2048x1536 — 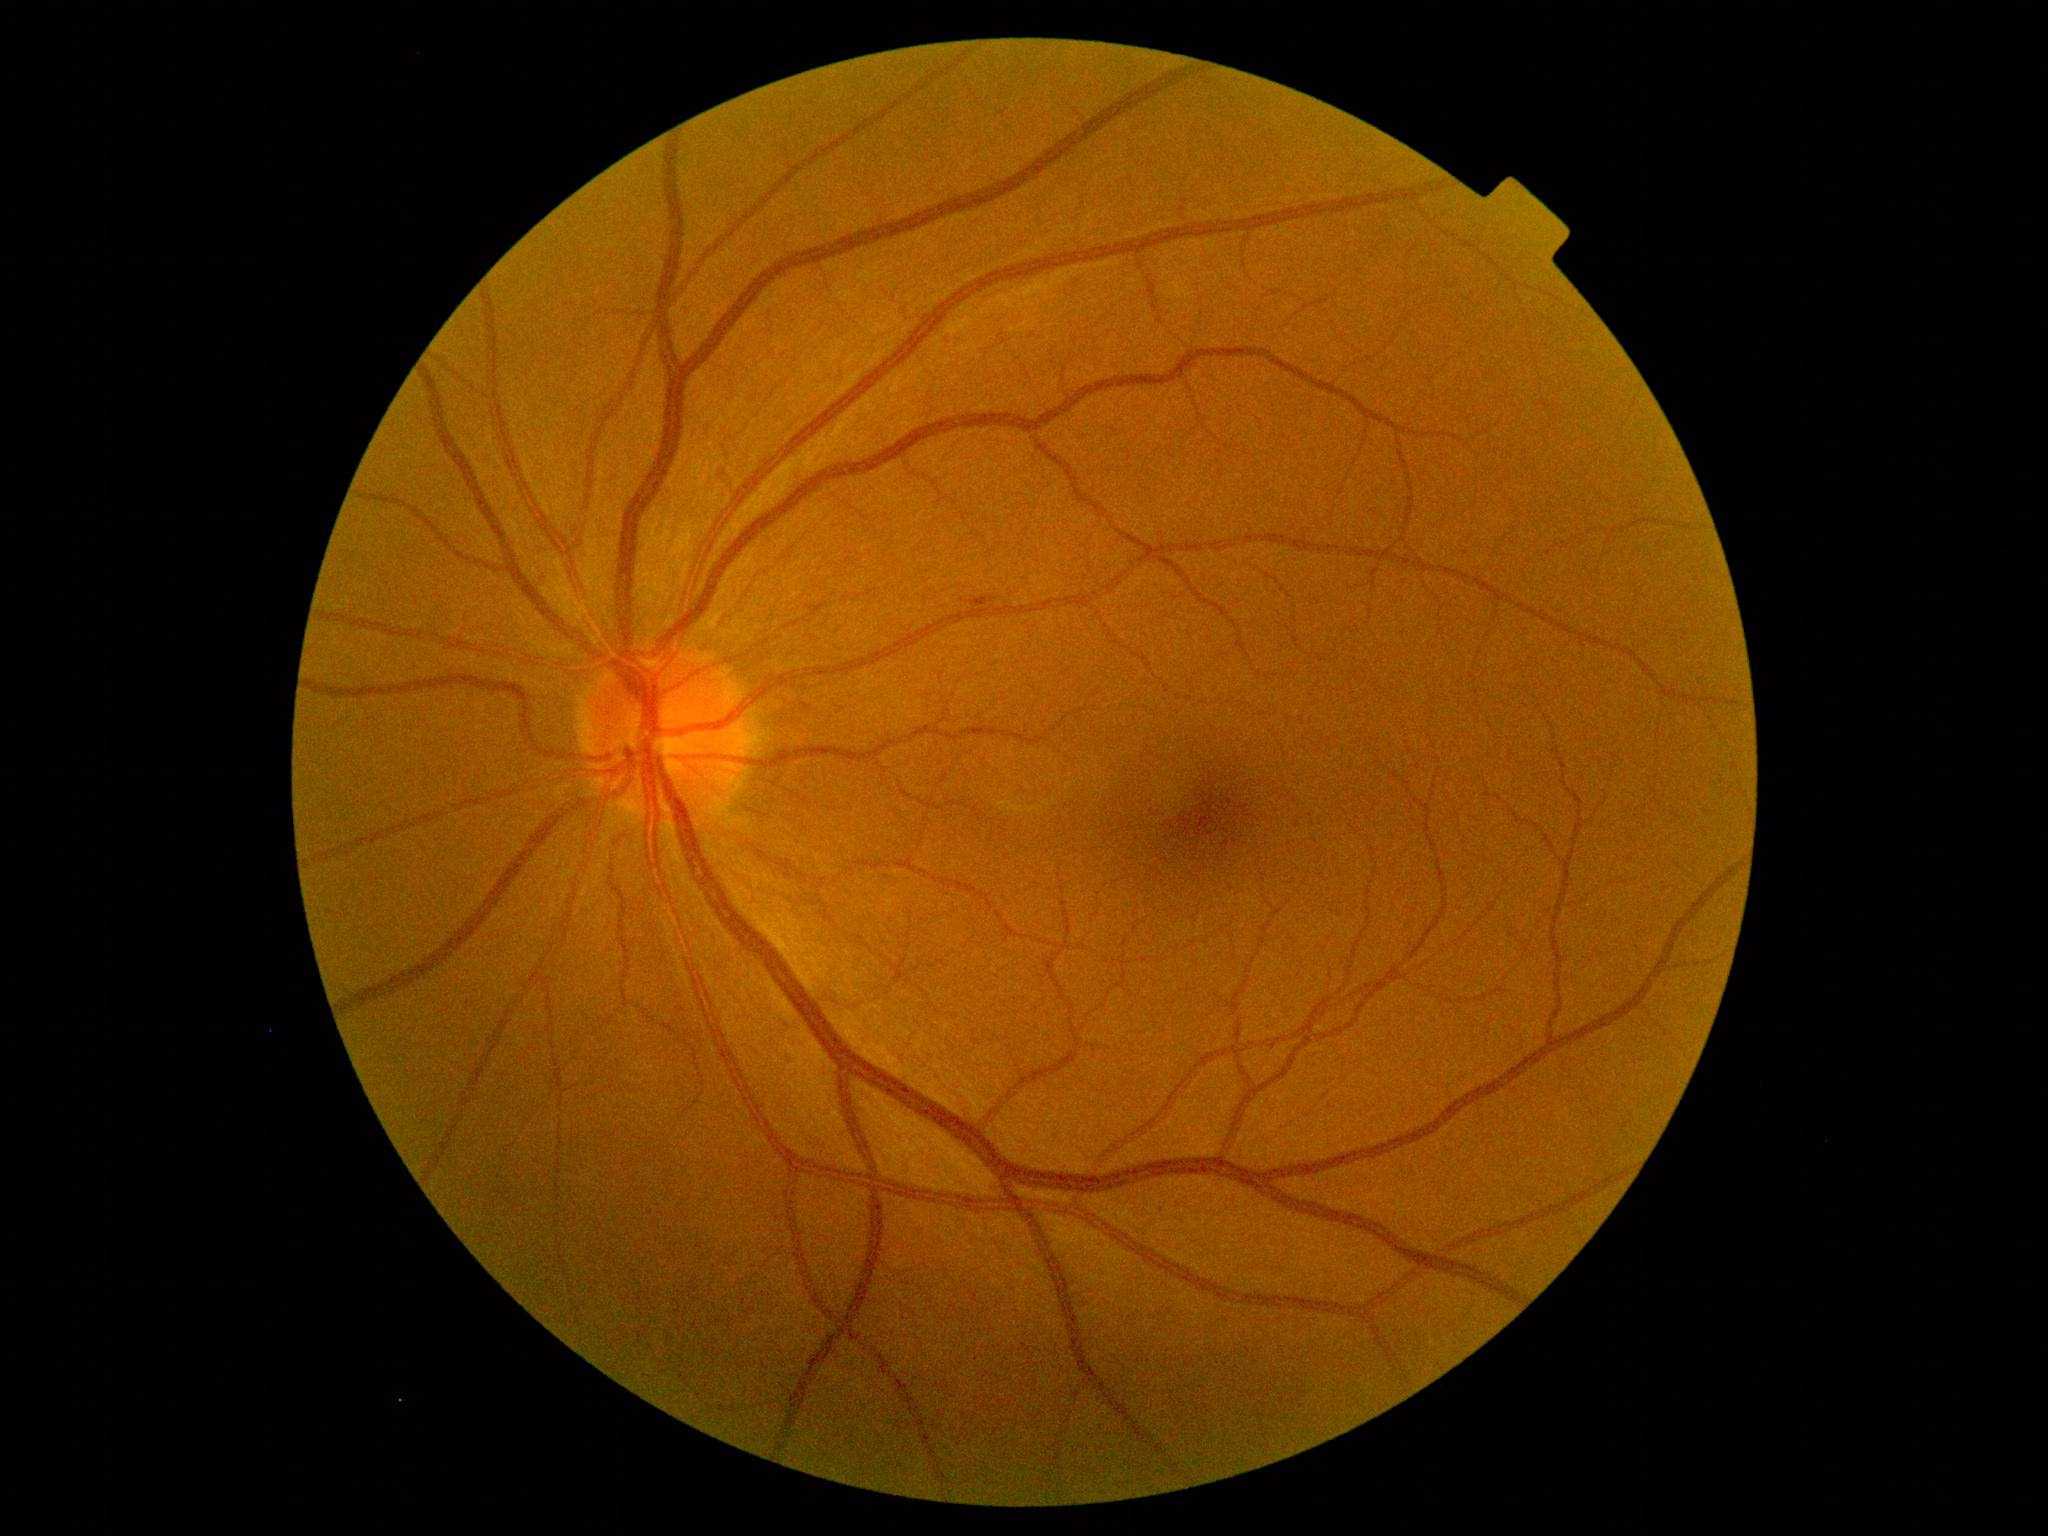

diabetic retinopathy (DR): mild NPDR (grade 1)